No pharmacologic dilation. NIDEK AFC-230. Modified Davis grading:
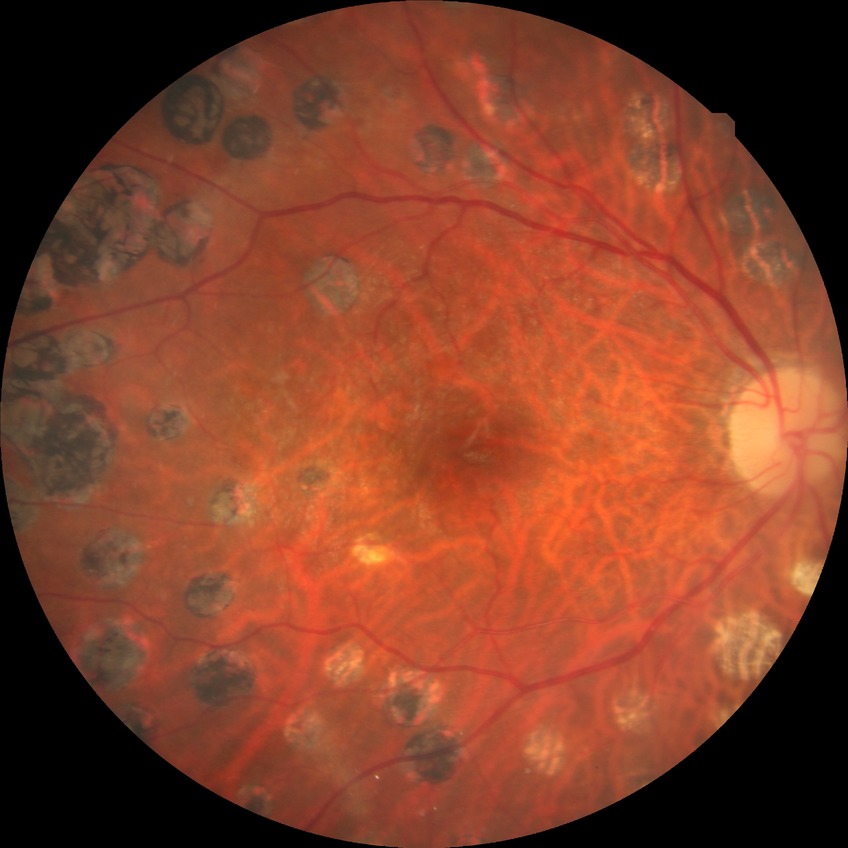 {"davis_grade": "PDR"}